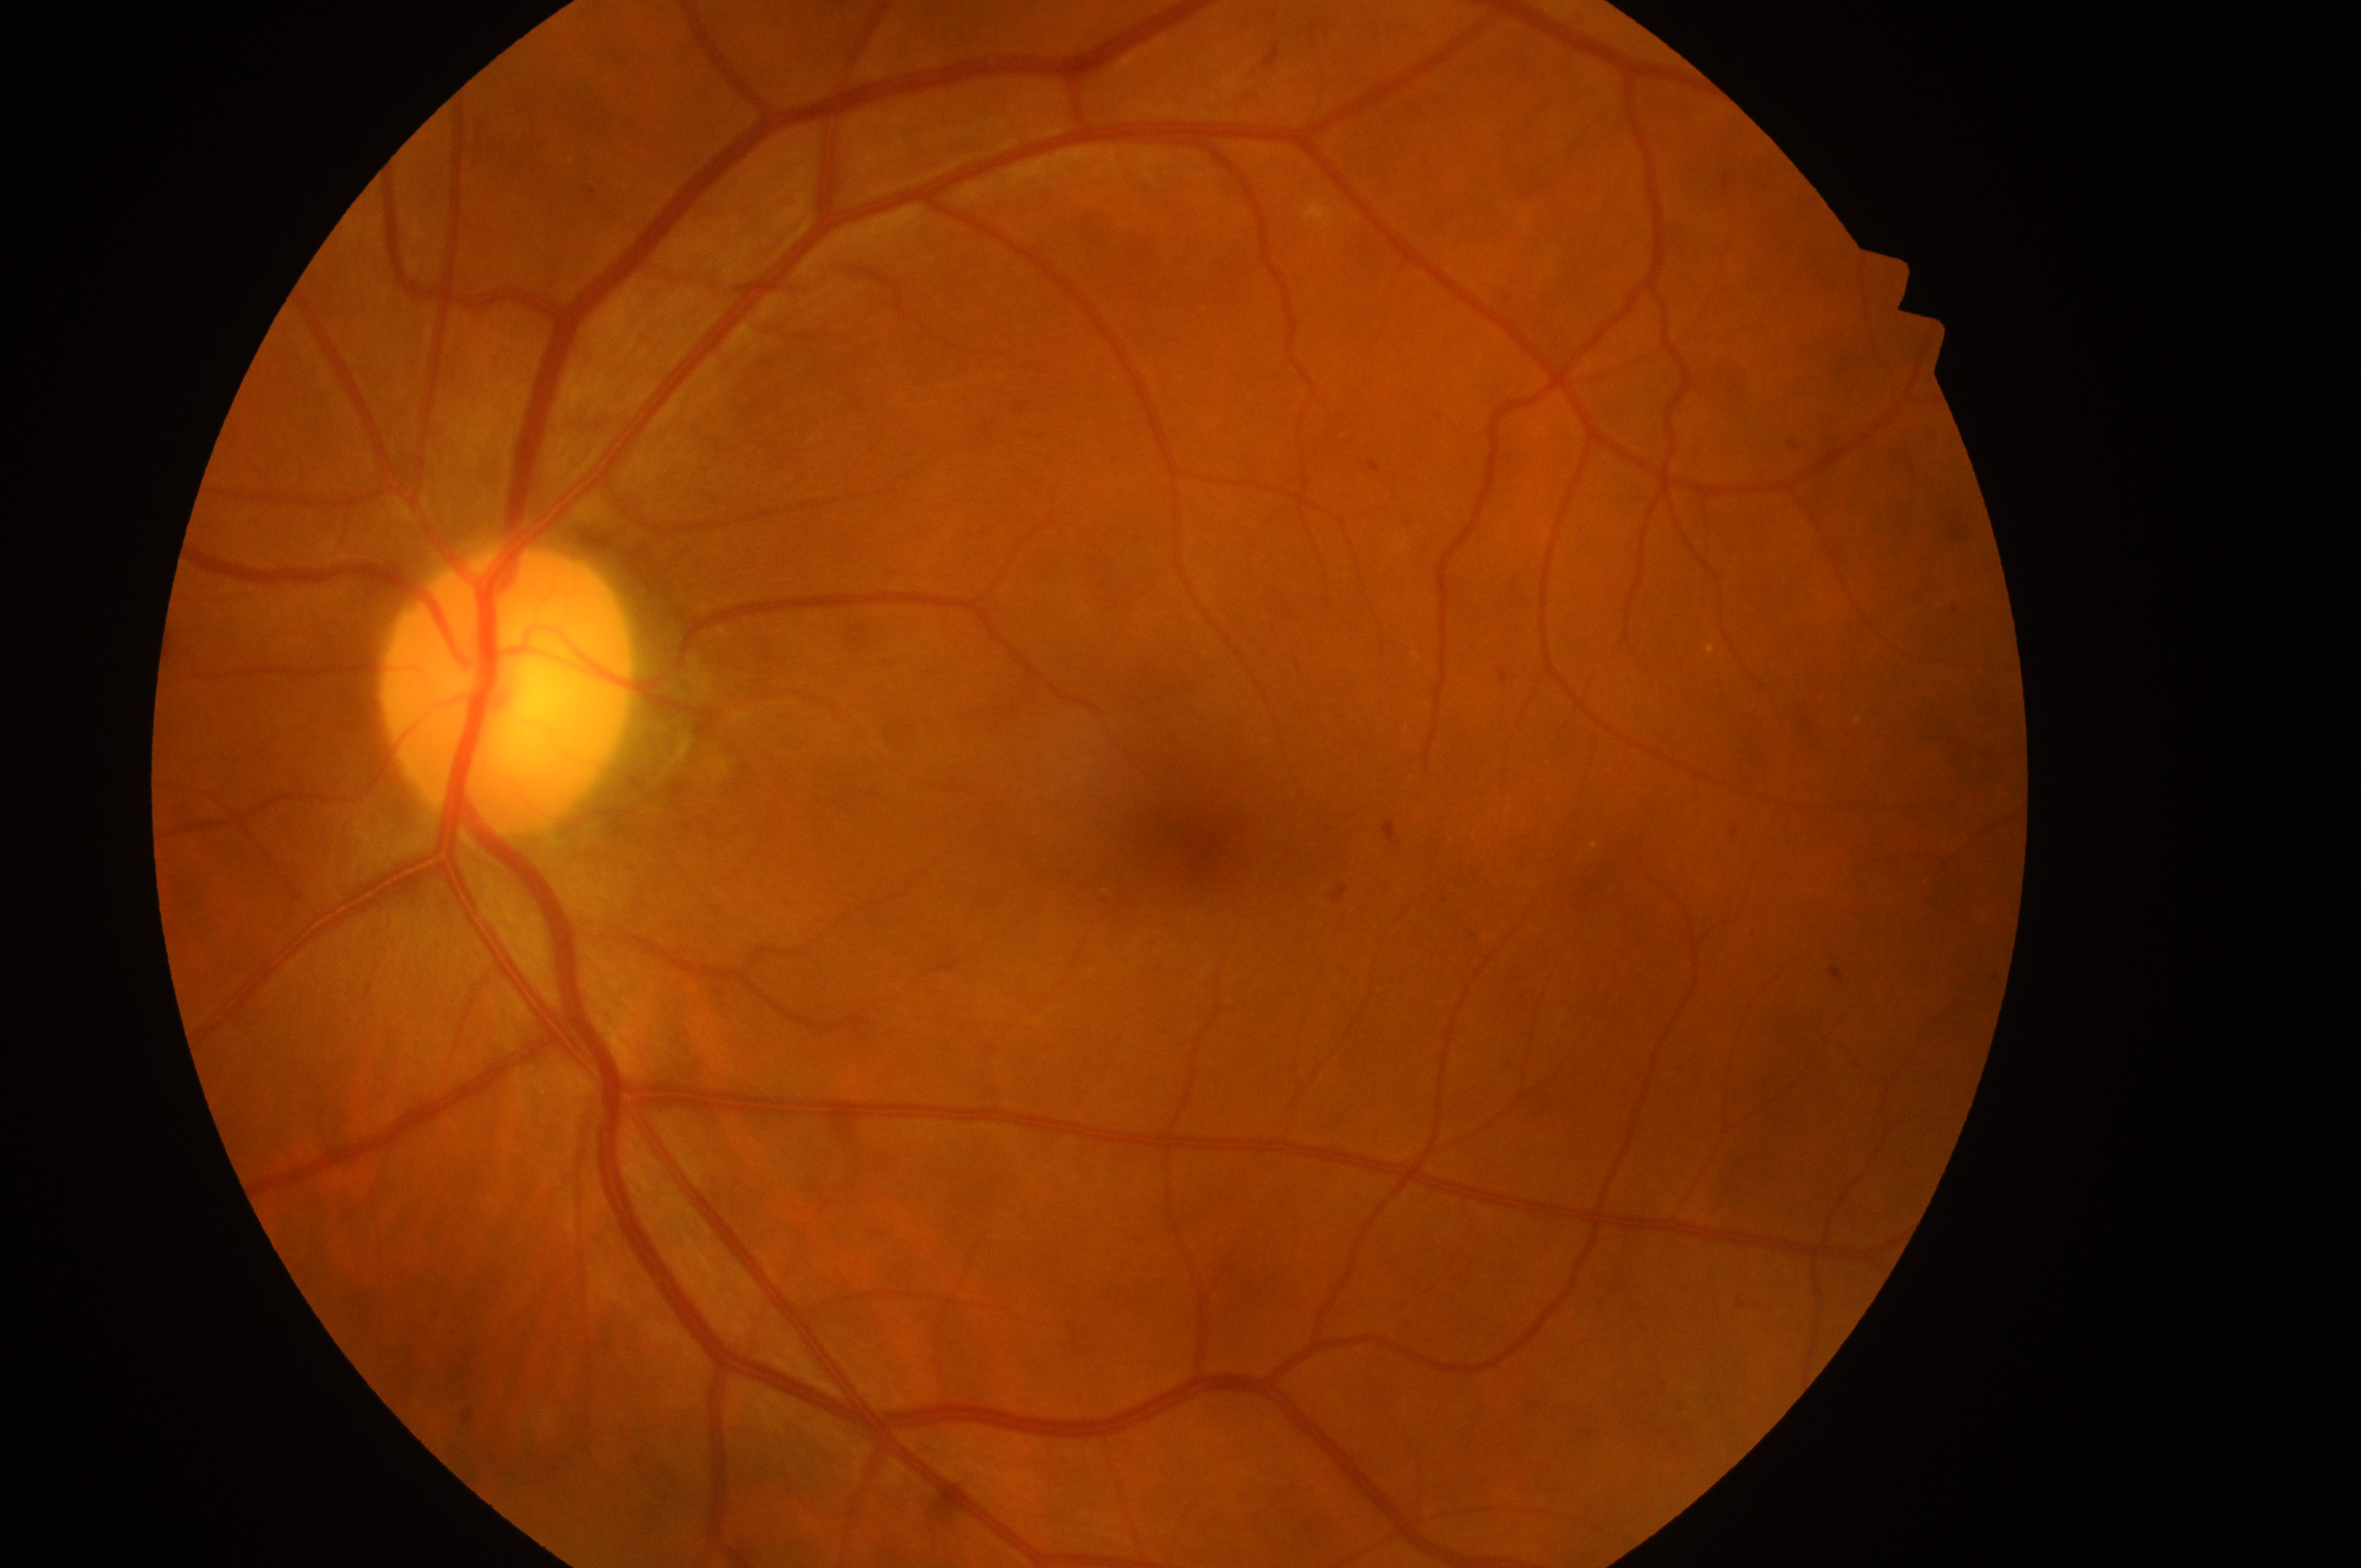

retinopathy=grade 2 (moderate NPDR)
macula center=1200px, 843px
oculus sinister
optic disk=503px, 703px
risk of diabetic macular edema=low risk (grade 1)